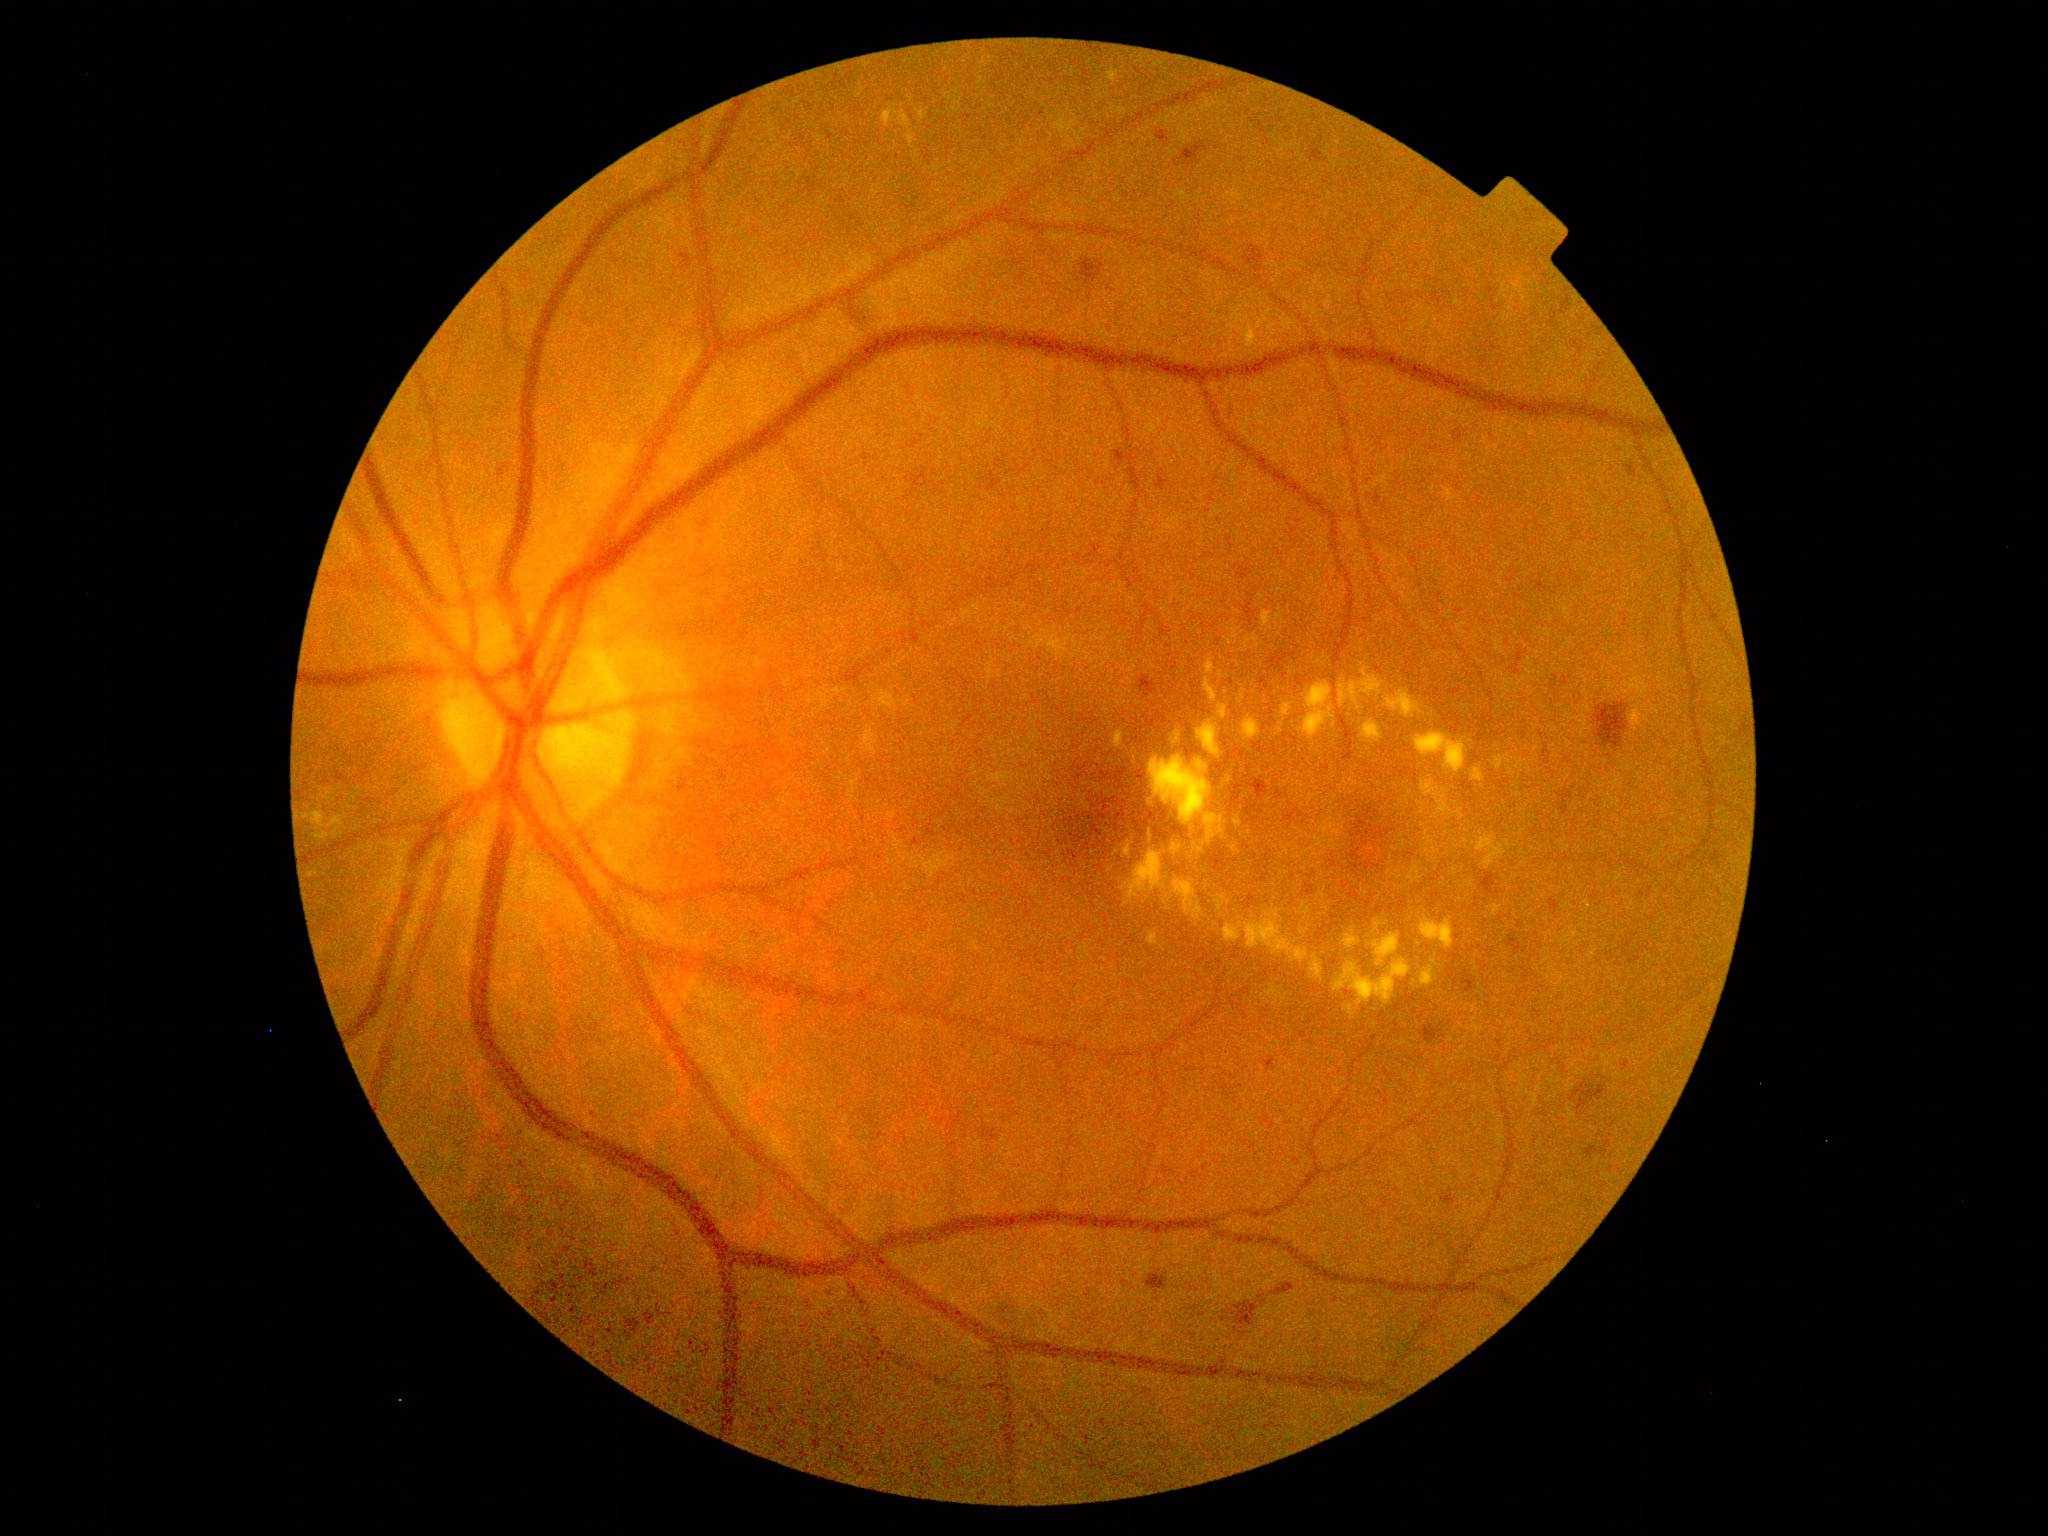
<lesions partial="true">
  <dr_grade>2</dr_grade>
  <ex partial="true">[1281, 872, 1289, 878] | [1421, 776, 1454, 819] | [1216, 703, 1231, 720] | [1461, 881, 1474, 889] | [1504, 840, 1512, 849] | [1148, 932, 1159, 947] | [1149, 830, 1152, 839] | [1267, 985, 1288, 1007] | [883, 104, 911, 130]</ex>
  <ex_small>x=1252, y=976 | x=1362, y=886 | x=1137, y=419 | x=1391, y=864 | x=1281, y=732 | x=1474, y=964 | x=1342, y=819 | x=1336, y=797 | x=1520, y=777 | x=1416, y=983</ex_small>
</lesions>